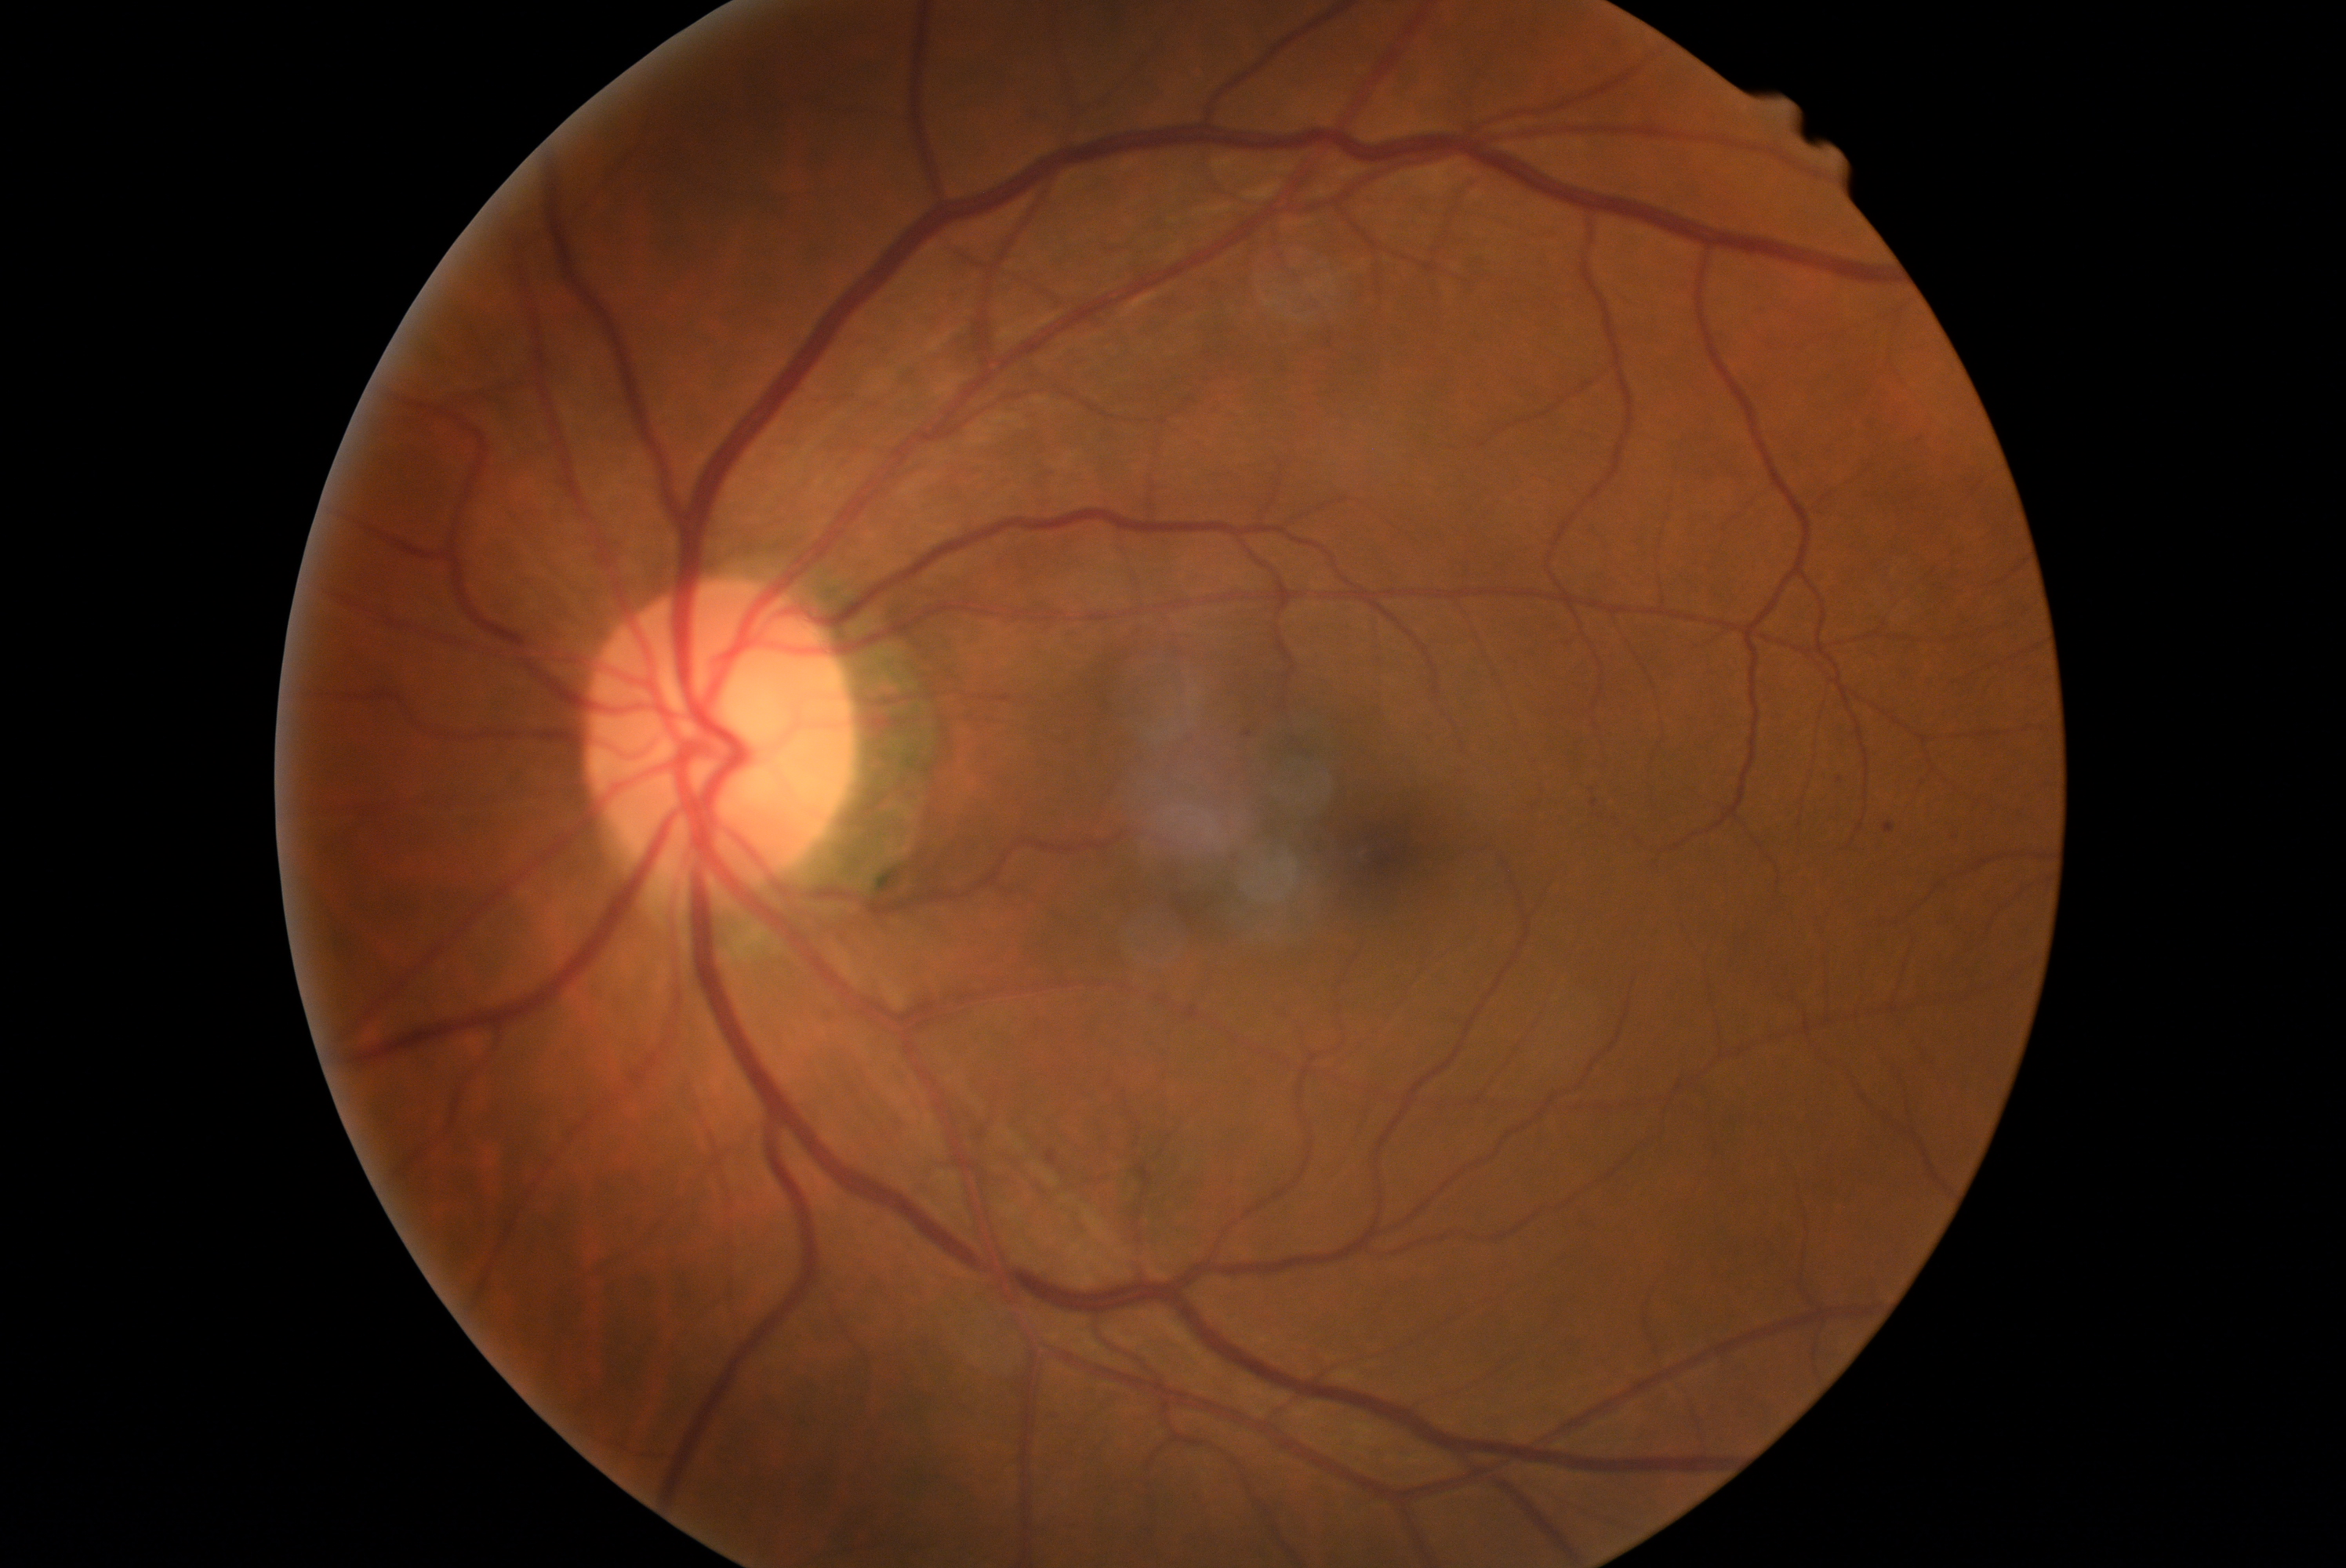 DR grade: 1/4.